Color fundus photograph — 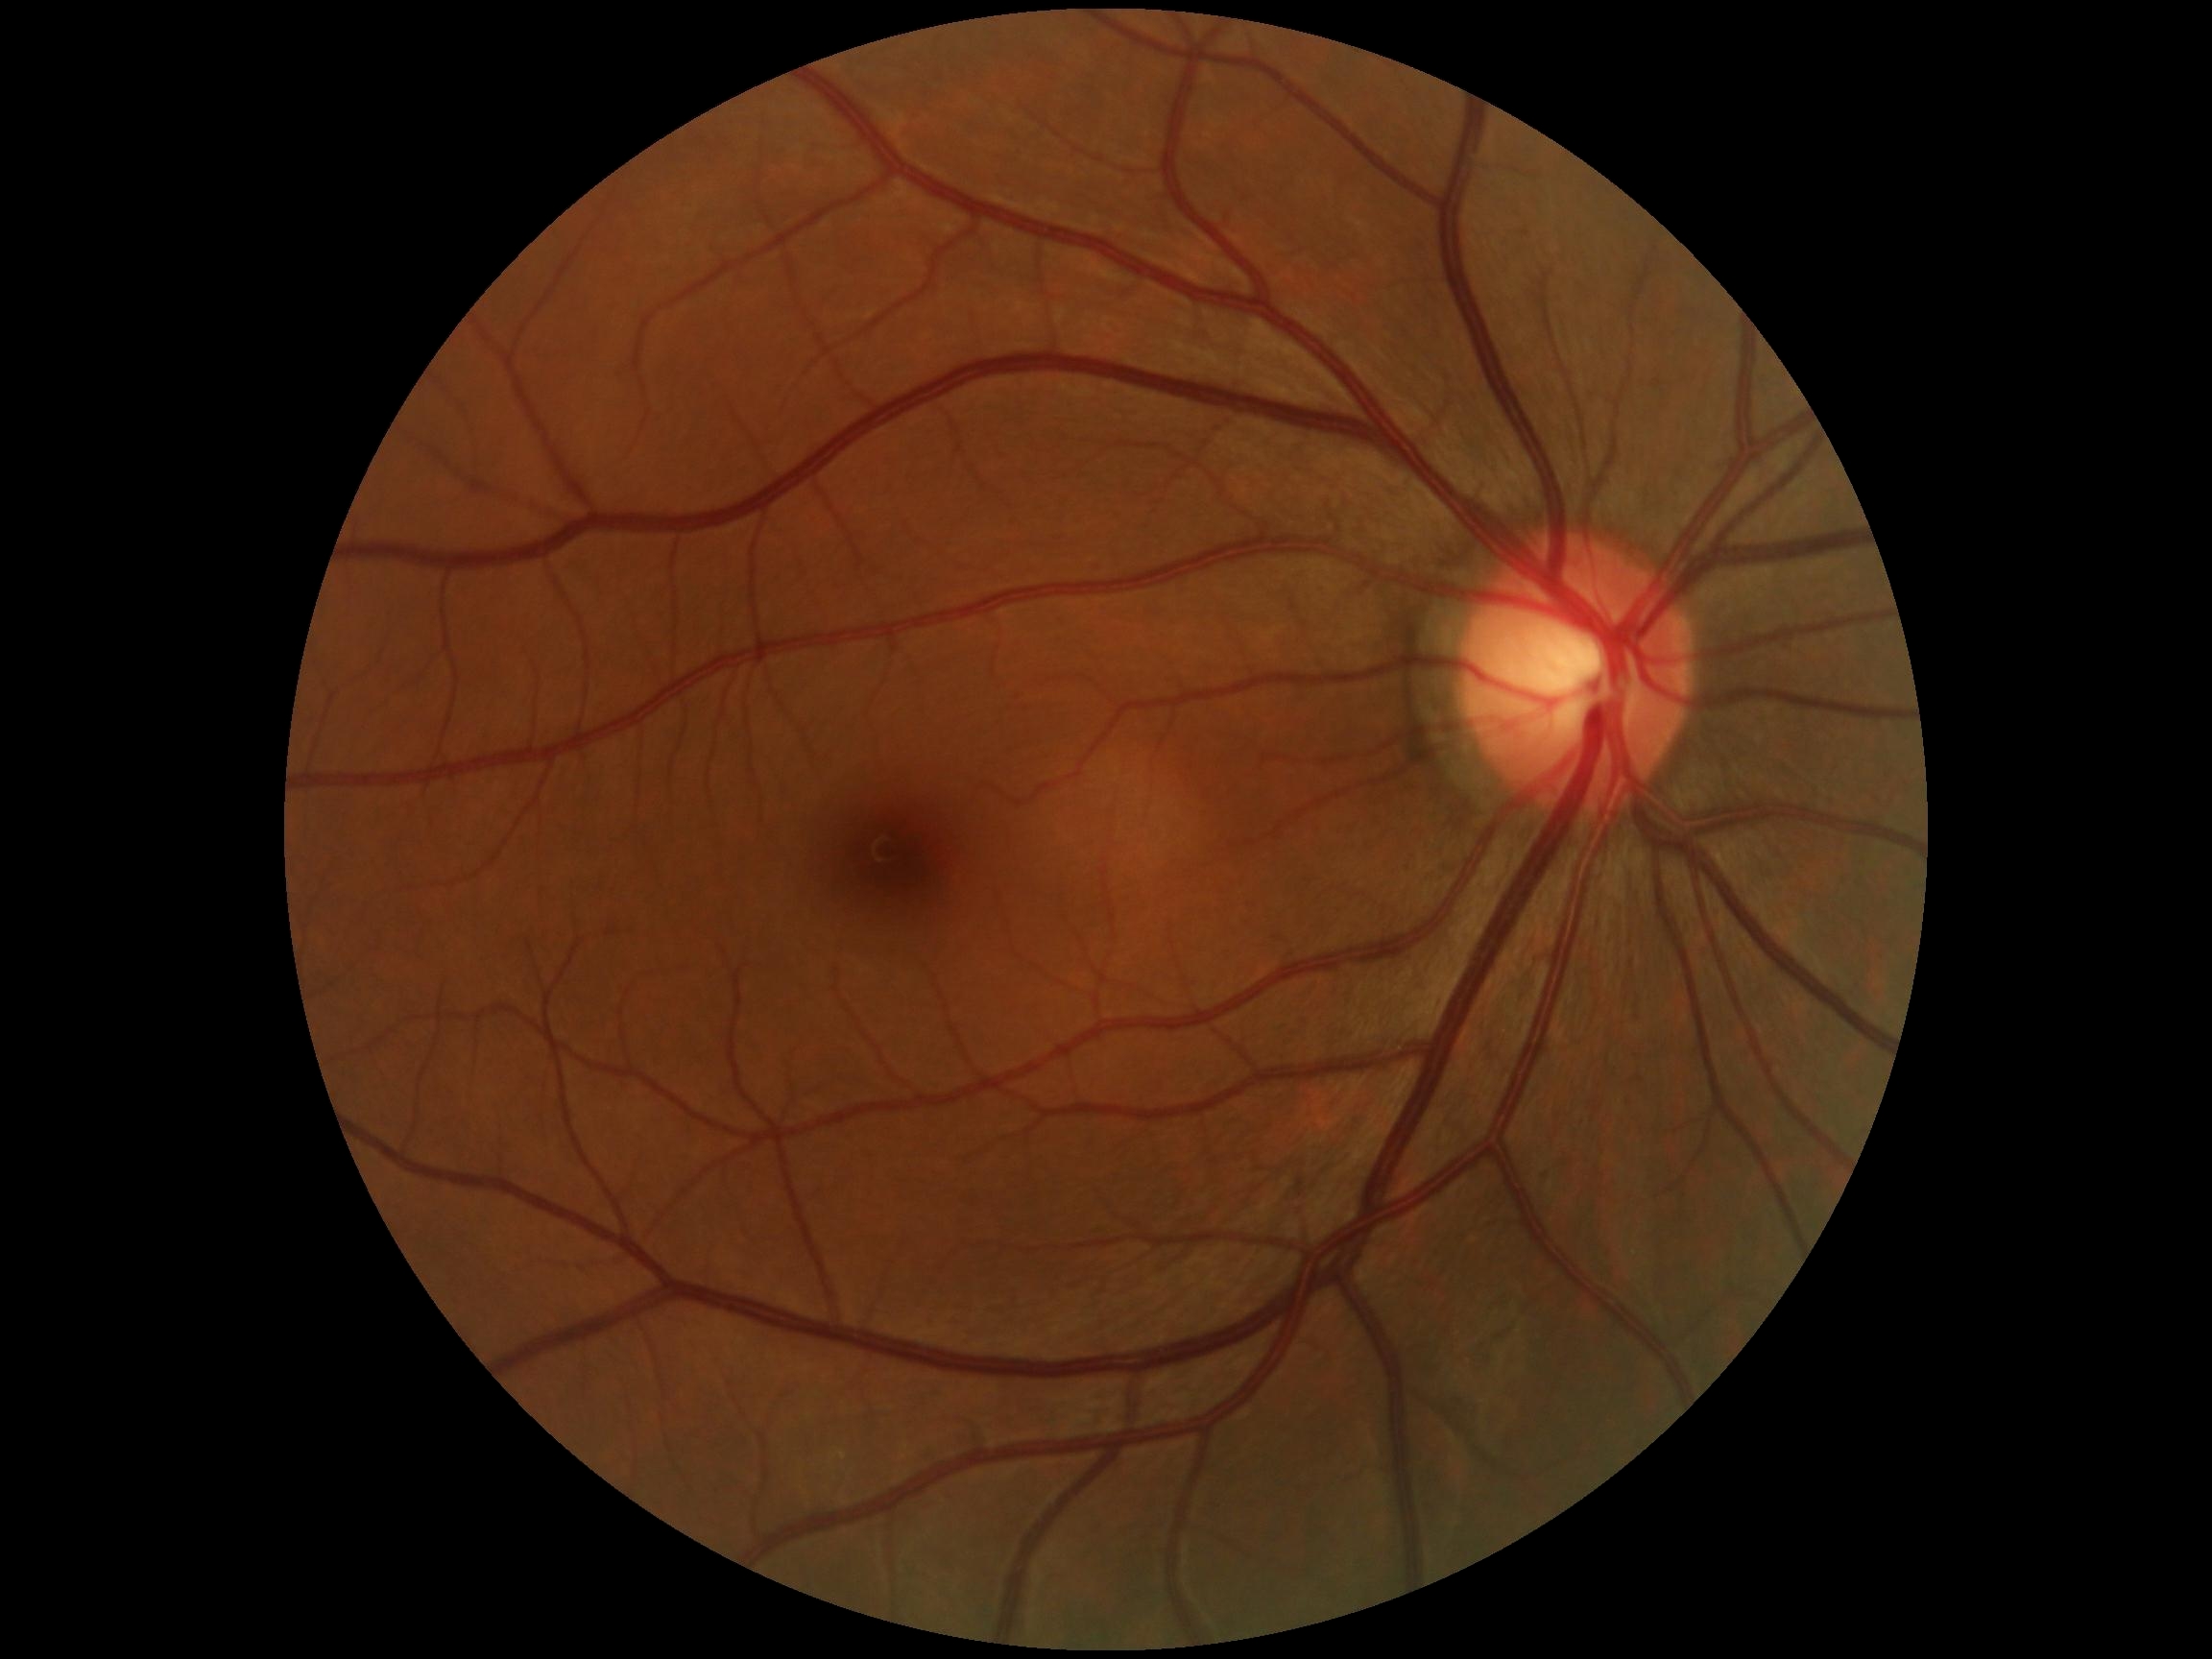
Diabetic retinopathy (DR): grade 0 (no apparent retinopathy) — no visible signs of diabetic retinopathy.